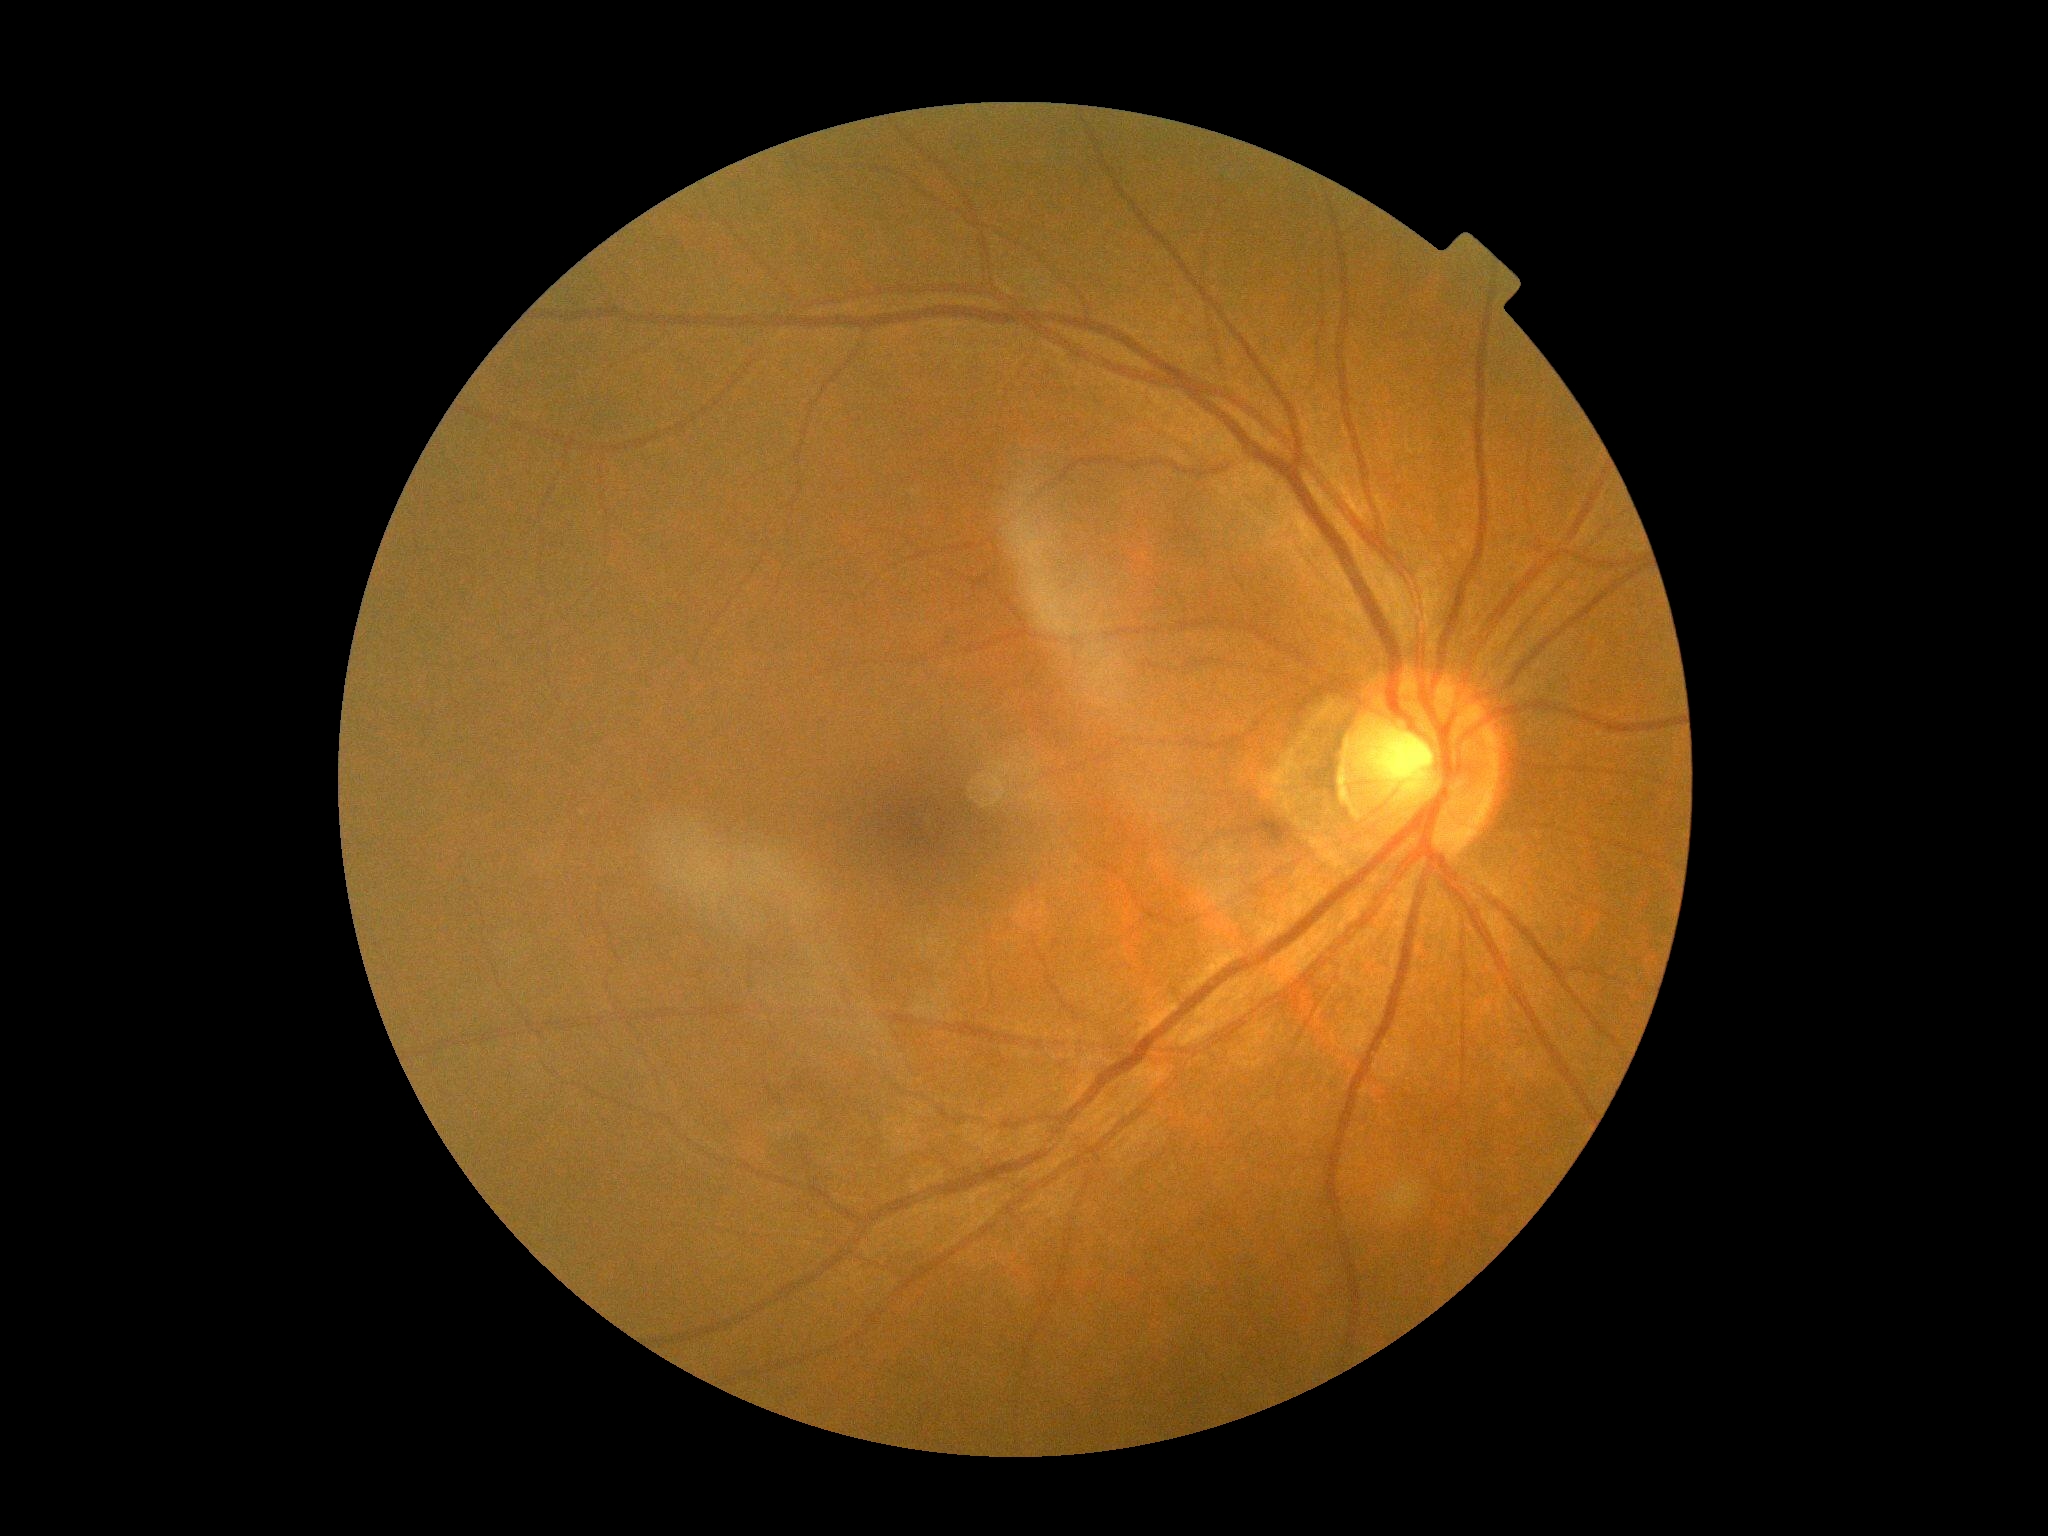
Diabetic retinopathy (DR): 0/4.